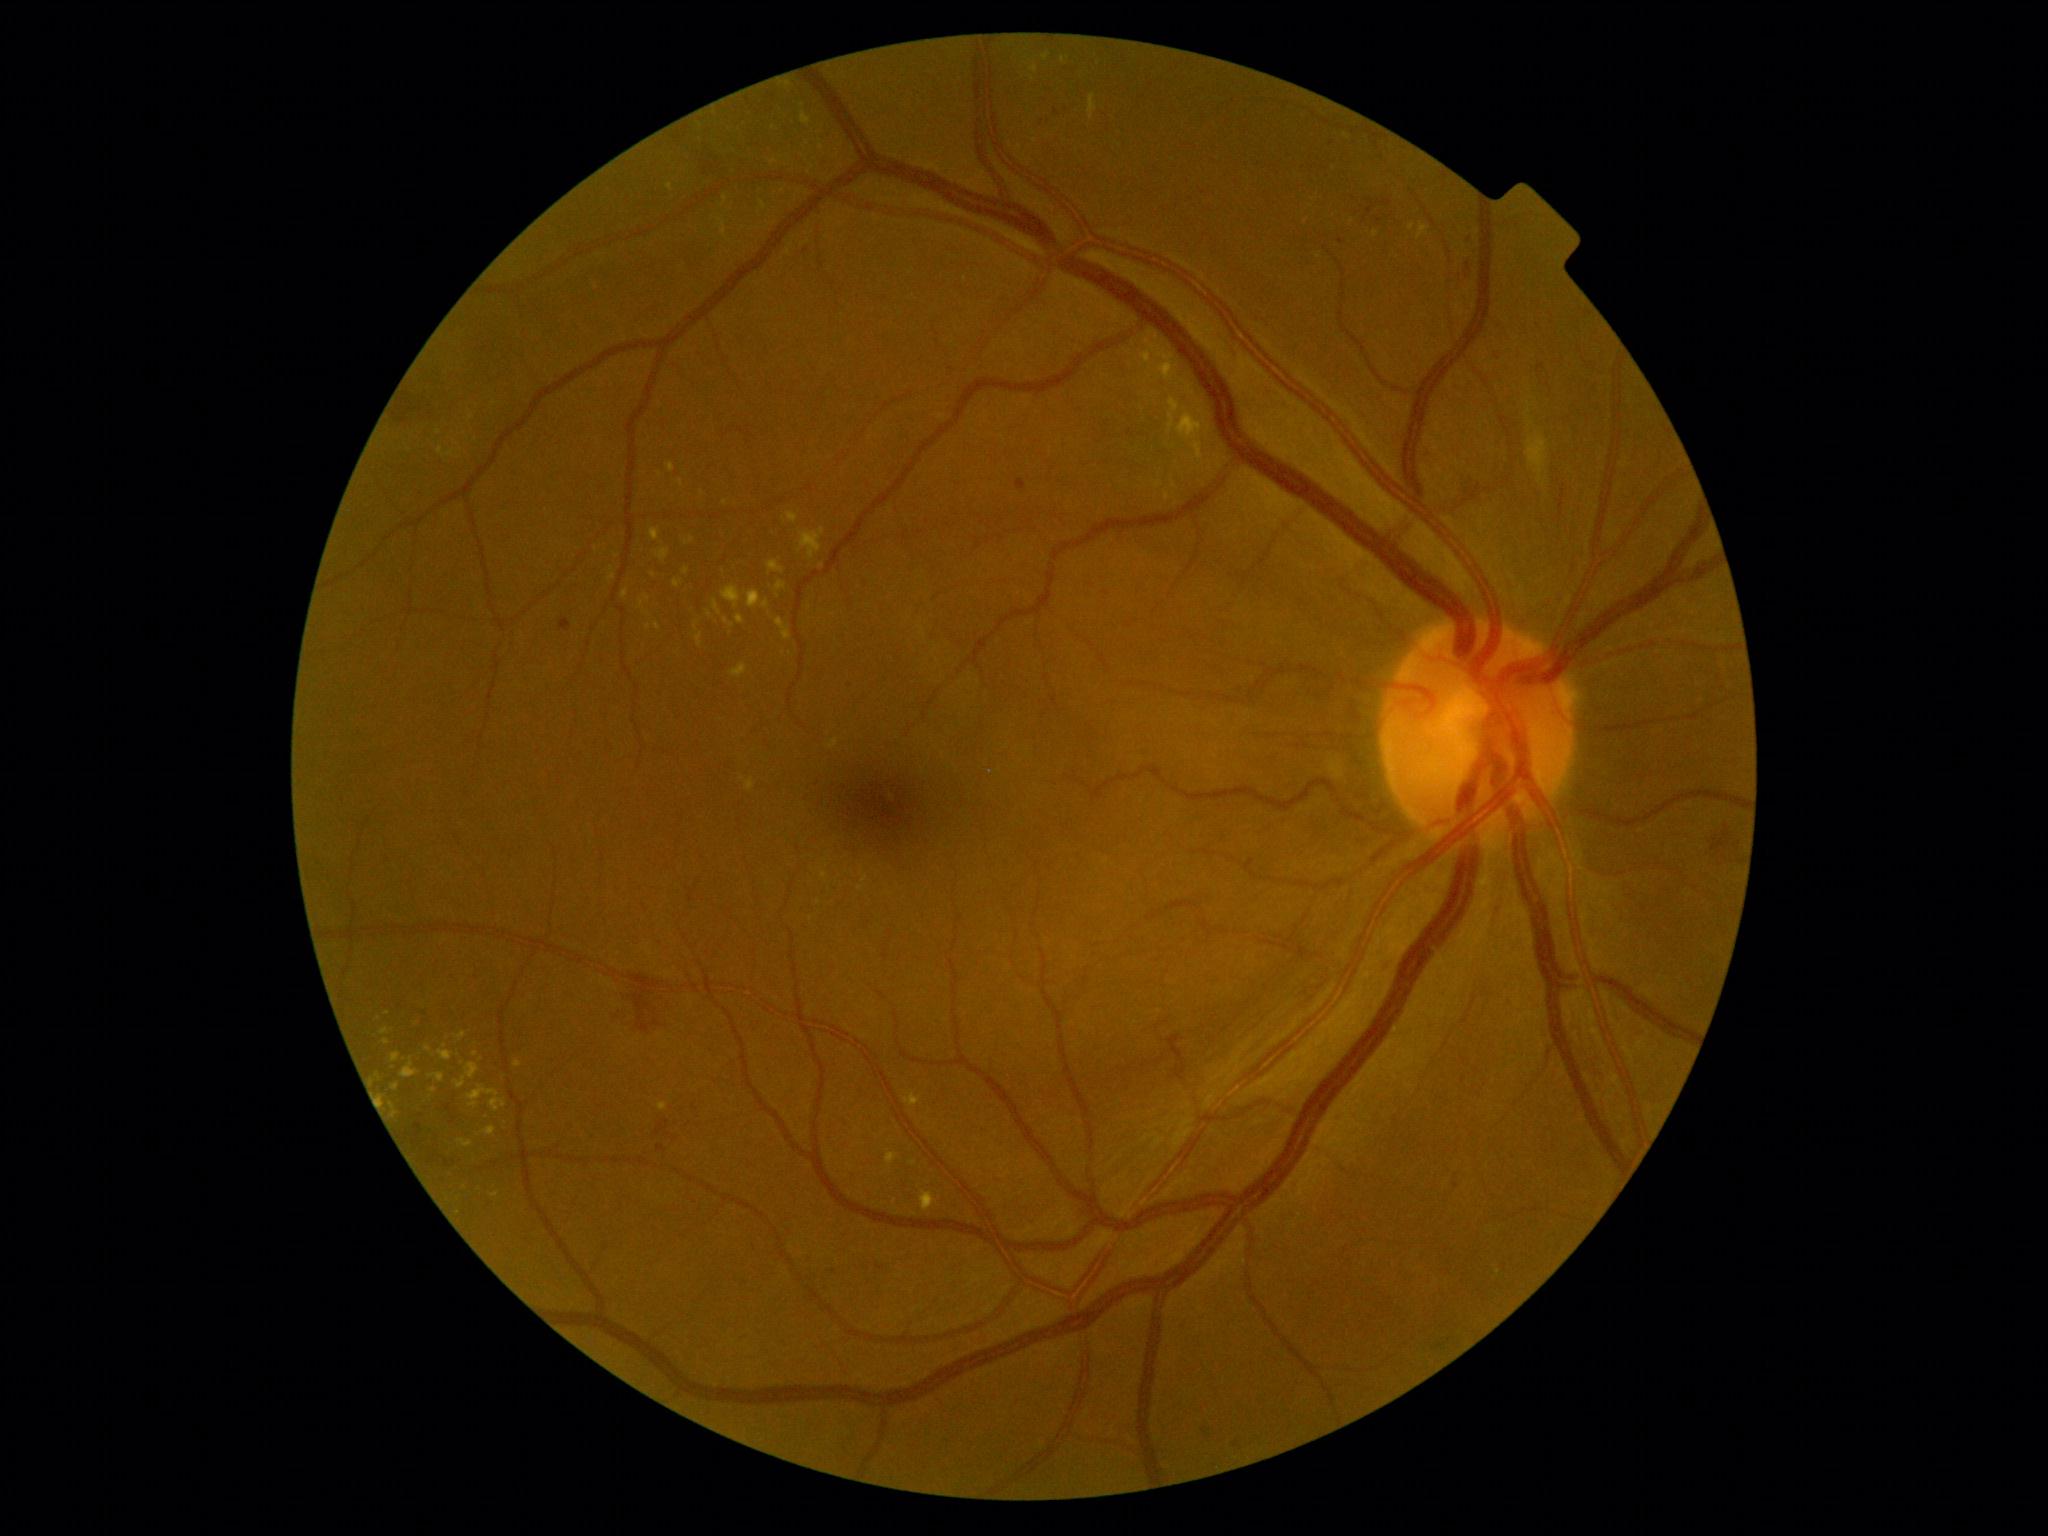
{"partial": true, "dr_grade": 2, "dr_grade_name": "moderate NPDR", "lesions": {"ex": [[492, 1191, 500, 1197], [513, 1059, 522, 1068], [456, 1032, 467, 1041], [721, 585, 741, 609], [1165, 490, 1170, 502], [730, 664, 749, 678], [1155, 480, 1163, 489], [1160, 366, 1169, 386], [802, 112, 812, 126], [608, 568, 617, 582], [655, 622, 661, 631], [650, 528, 661, 542]], "ex_small_approx": [[726, 621], [702, 493], [617, 555], [1319, 257], [387, 1042], [379, 1019], [861, 888]]}}